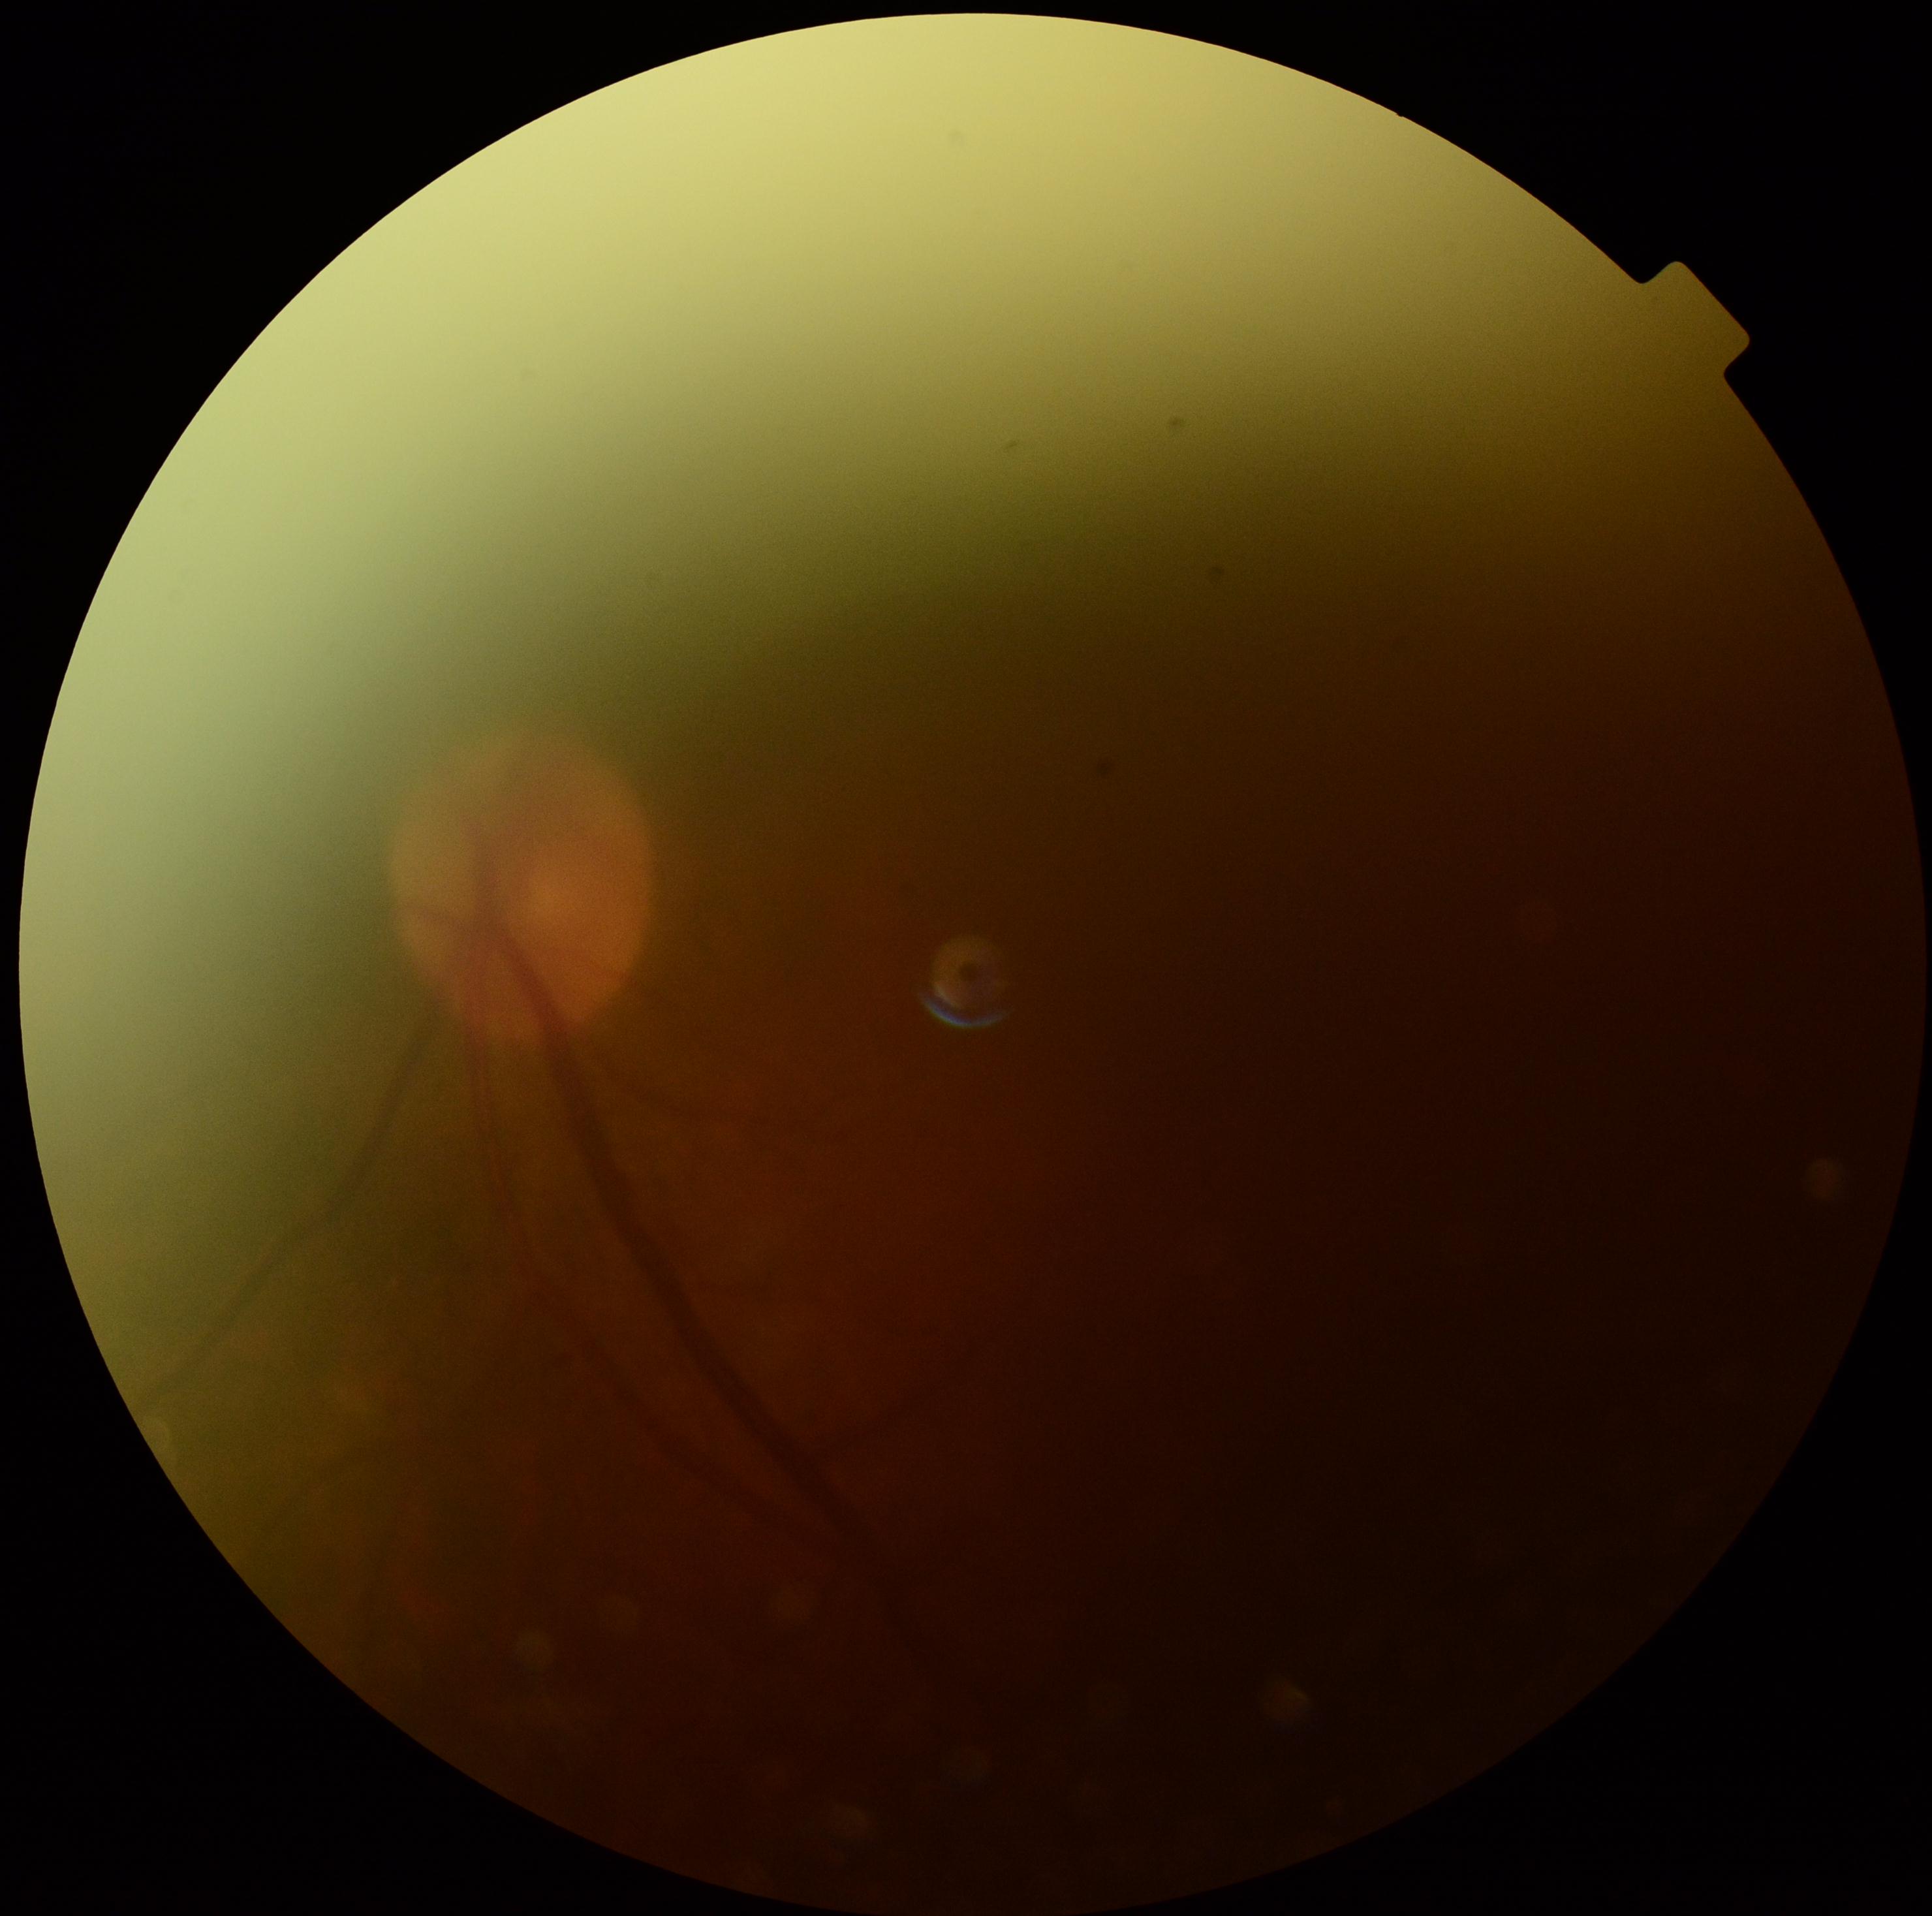
DR stage: ungradable.